50° field of view · posterior pole view: 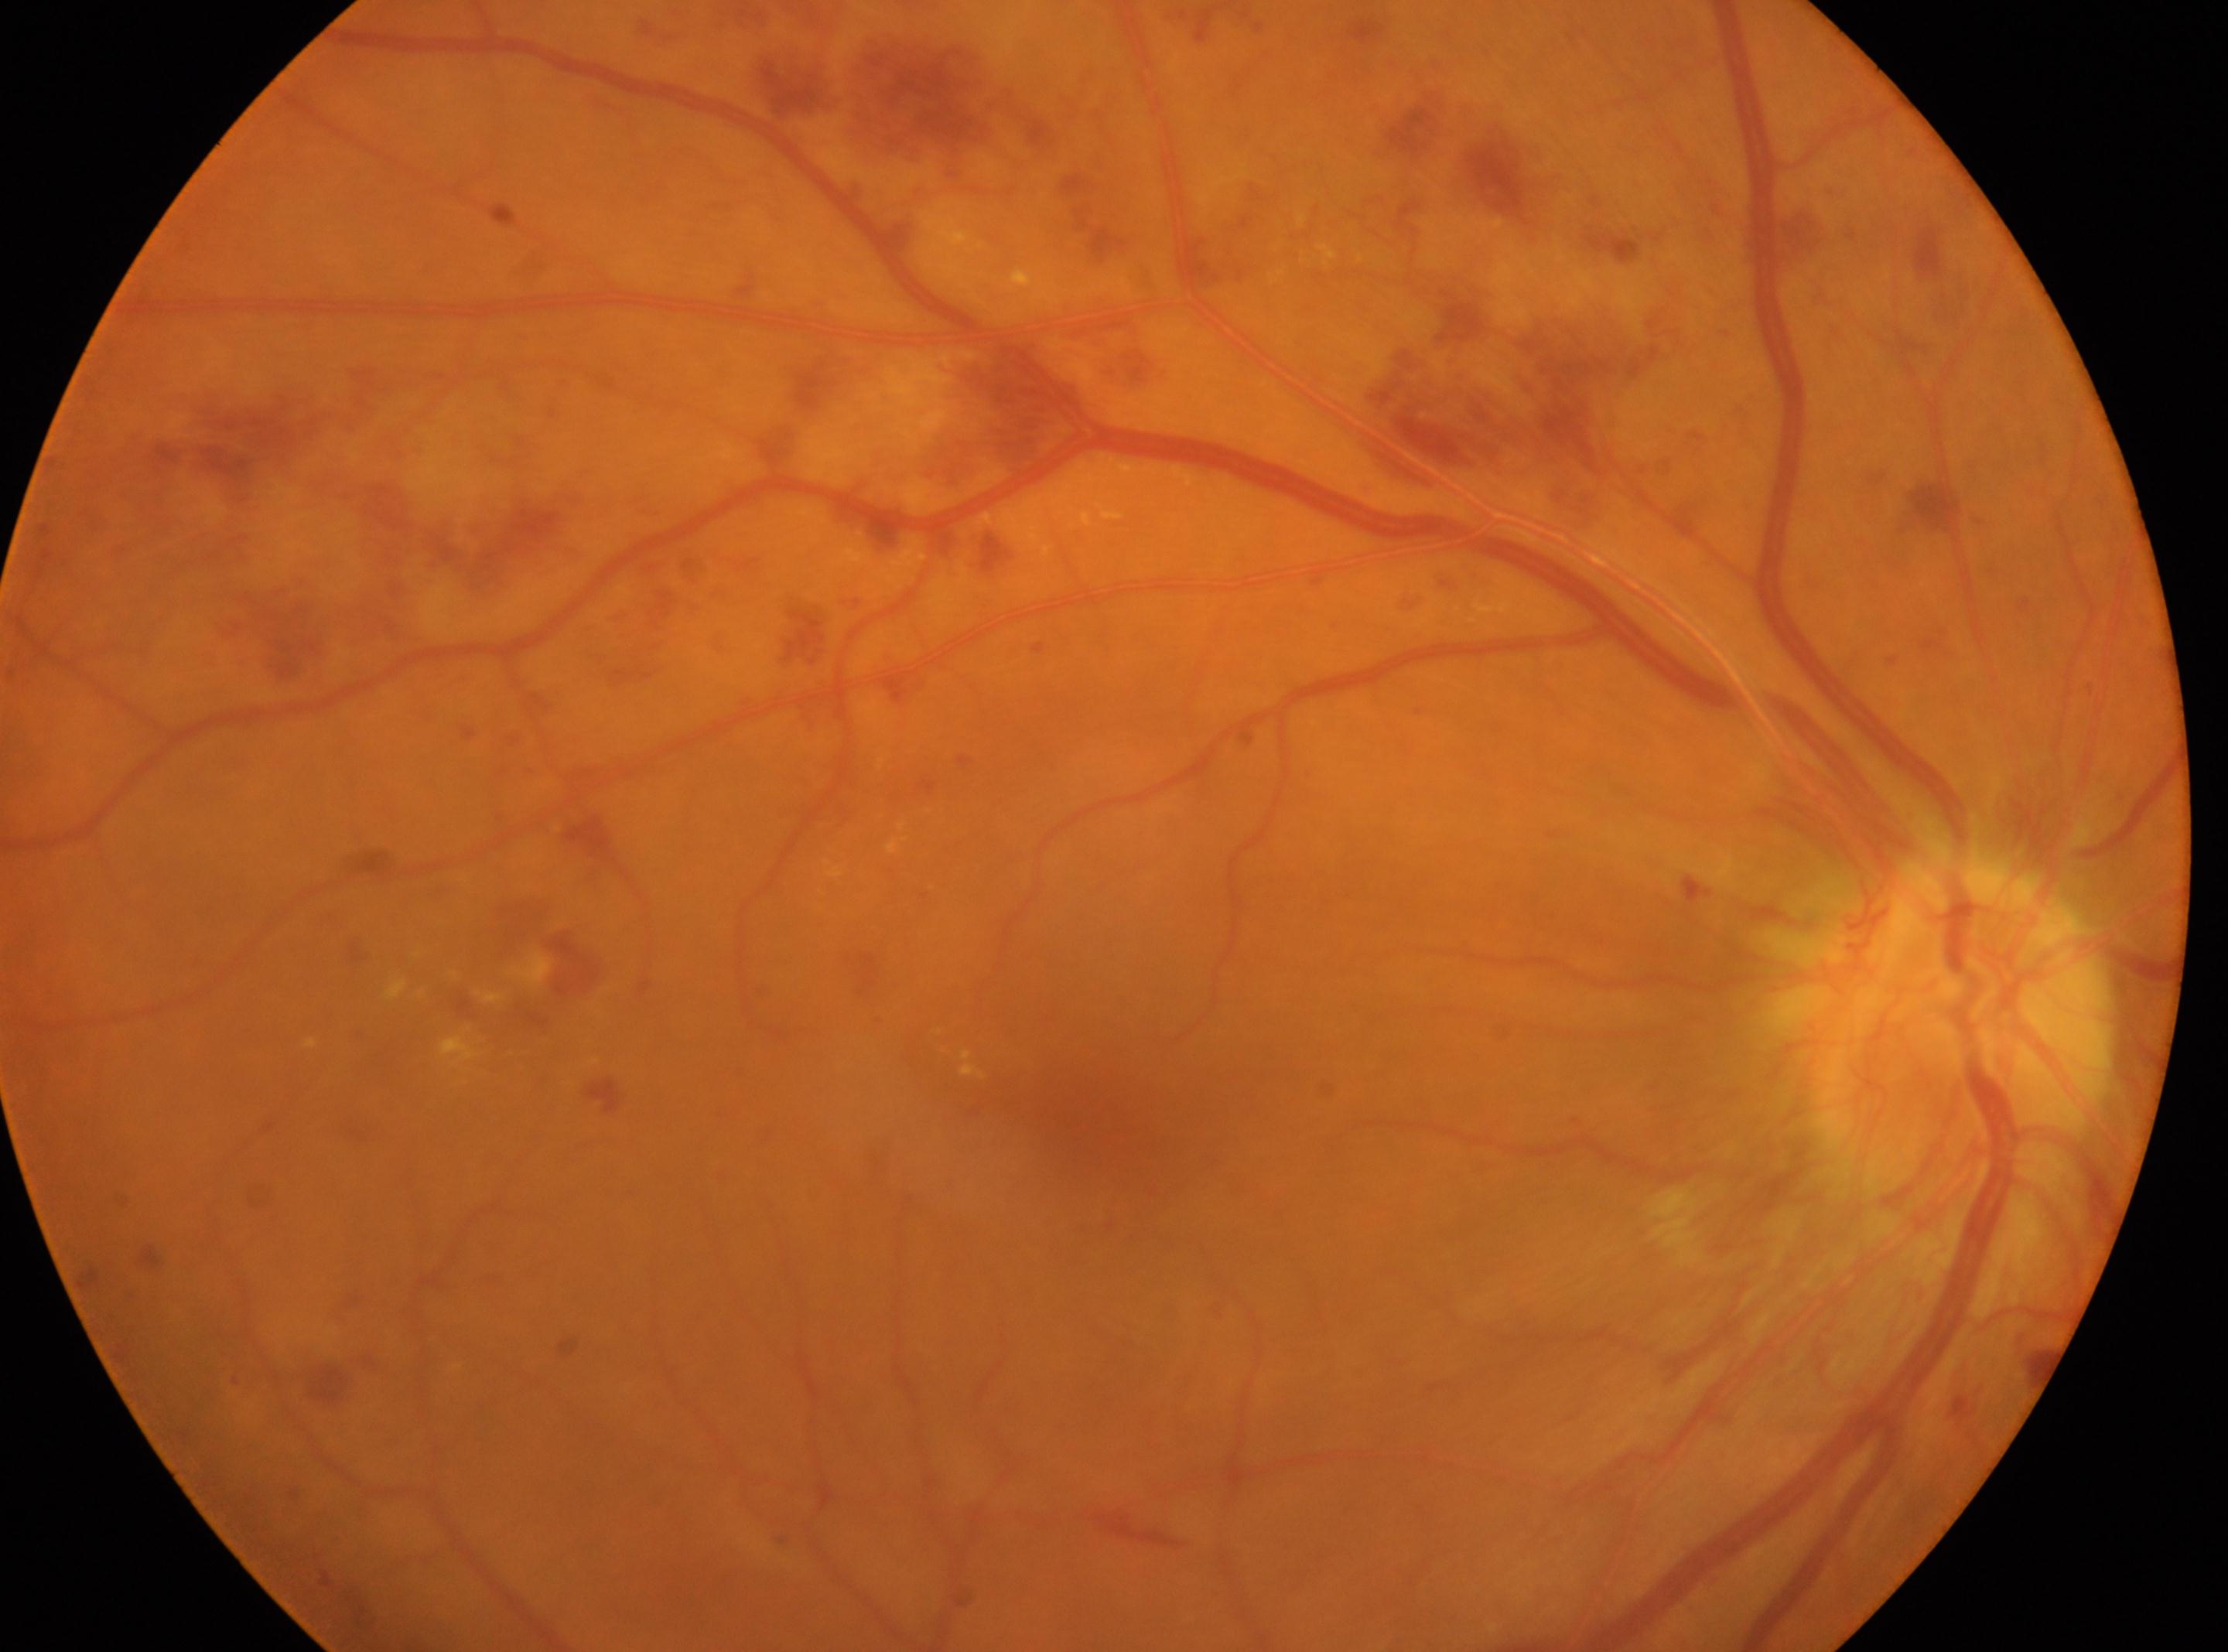

– diabetic retinopathy (DR) · PDR (grade 4)
– laterality · oculus dexter
– fovea center · (1078, 1112)
– disc center · (1955, 1029)